Phoenix ICON wide-field infant fundus image
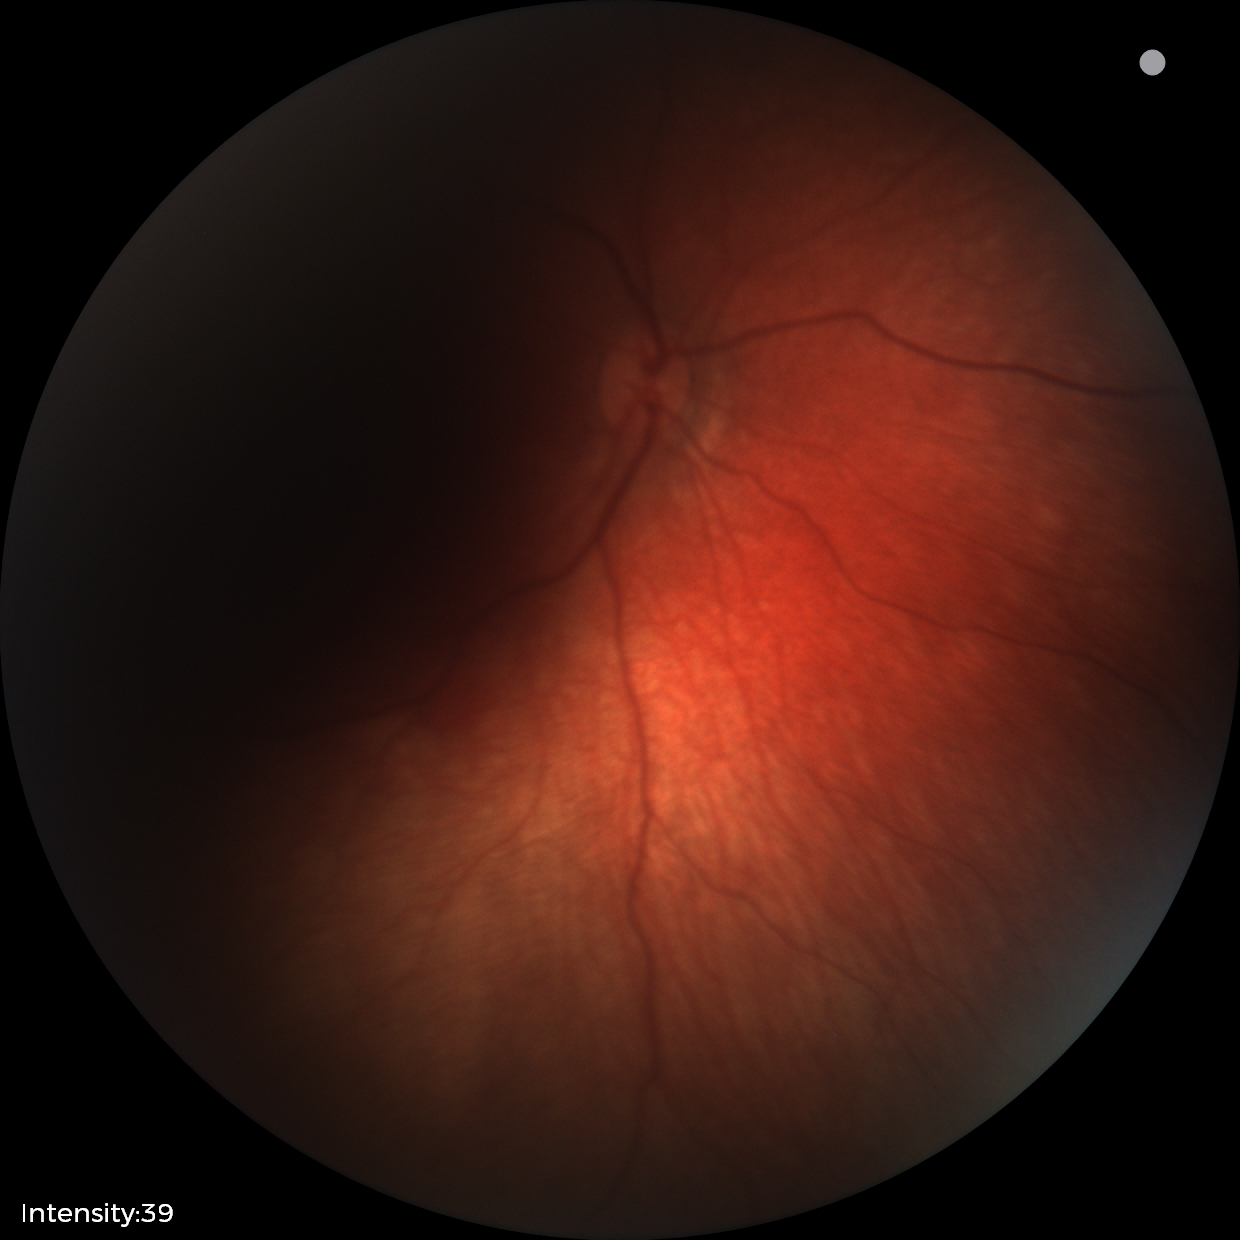
Screening examination consistent with retinal hemorrhages.